Color fundus photograph · FOV: 45 degrees:
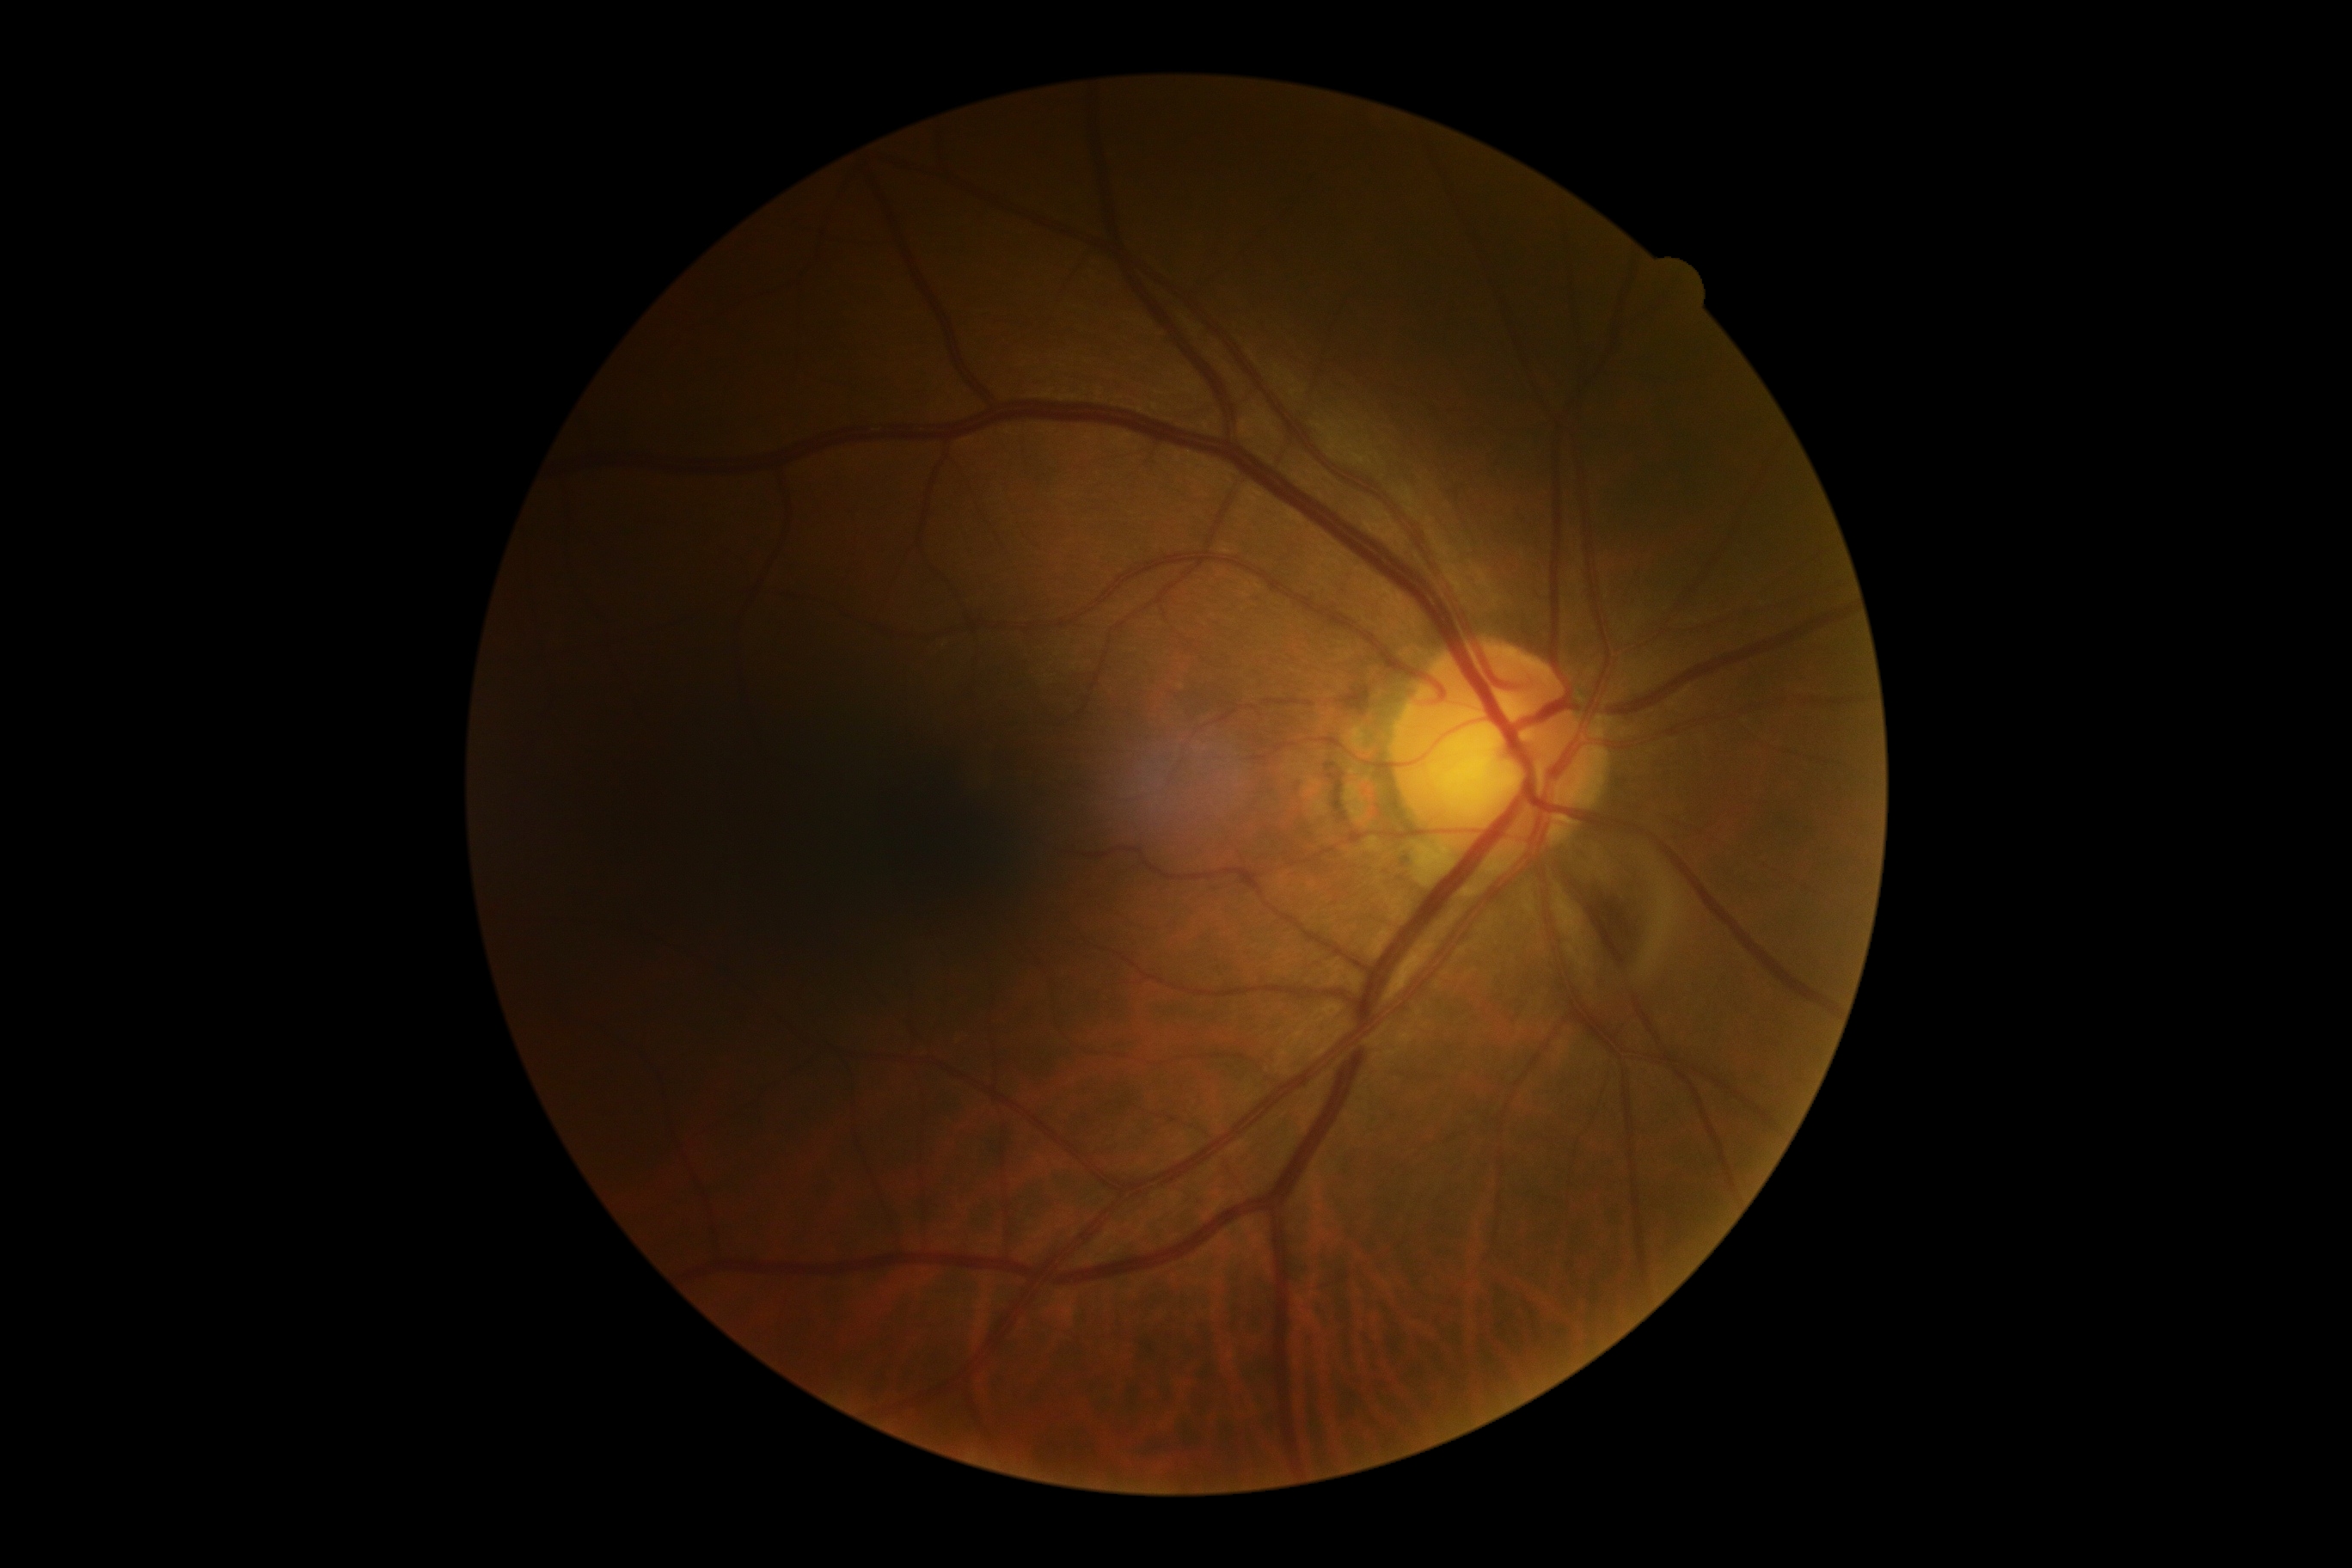 DR: grade 0 (no apparent retinopathy).